Infant wide-field fundus photograph. 100° field of view (Phoenix ICON)
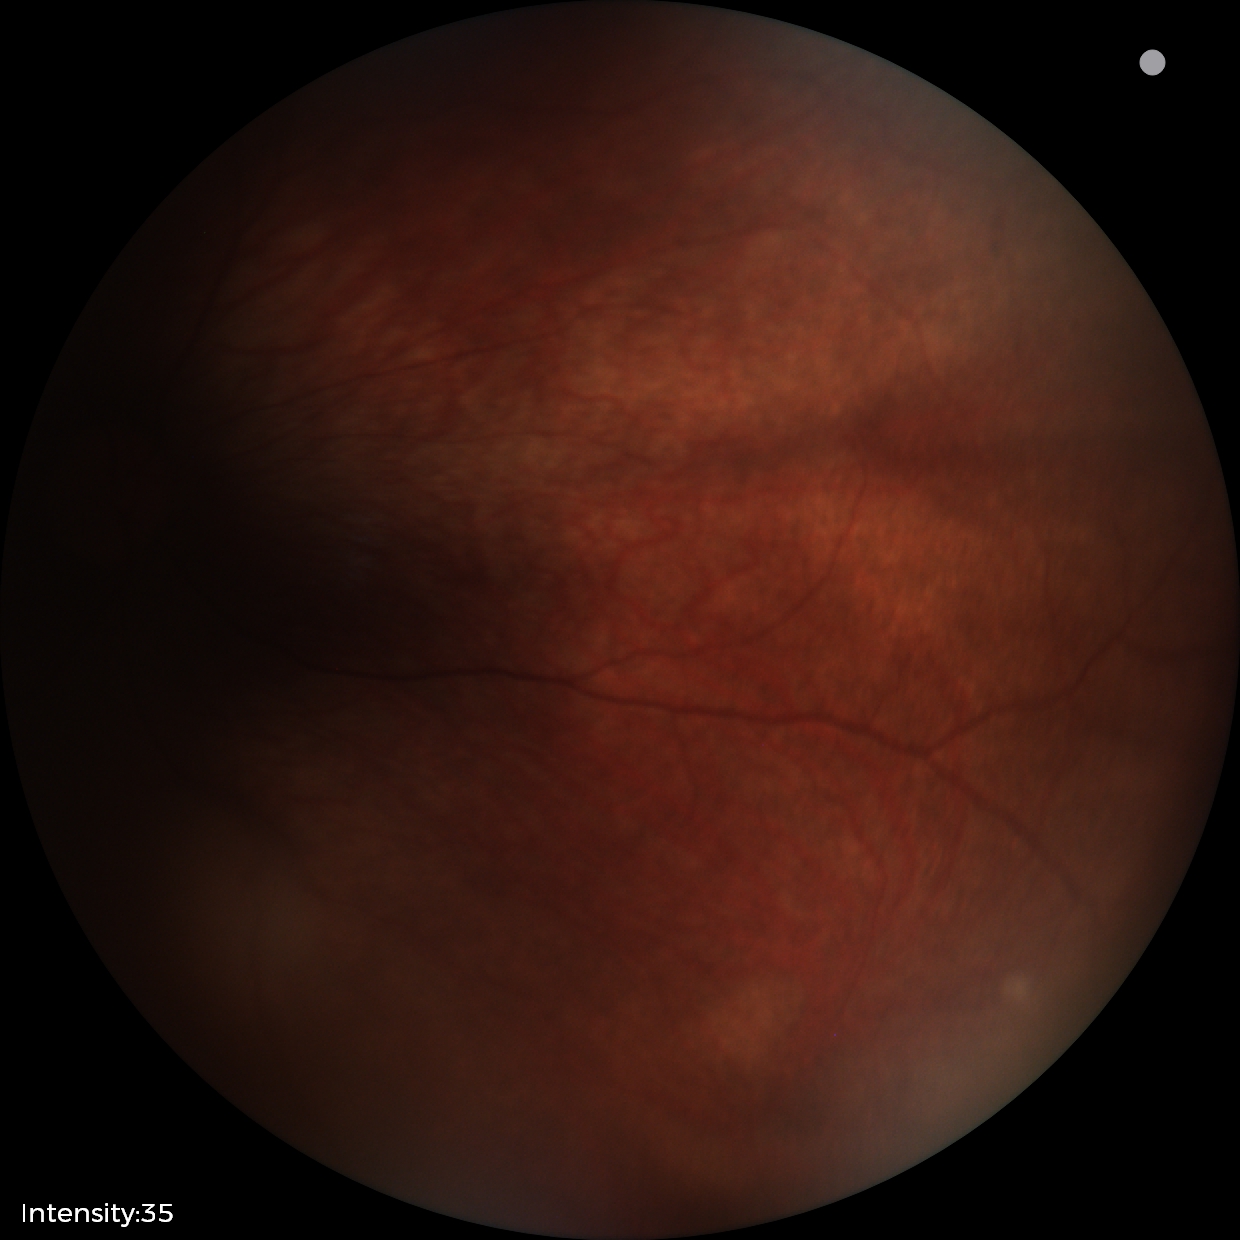 Screening diagnosis: retinal astrocytic hamartoma.